Wide-field fundus image from infant ROP screening.
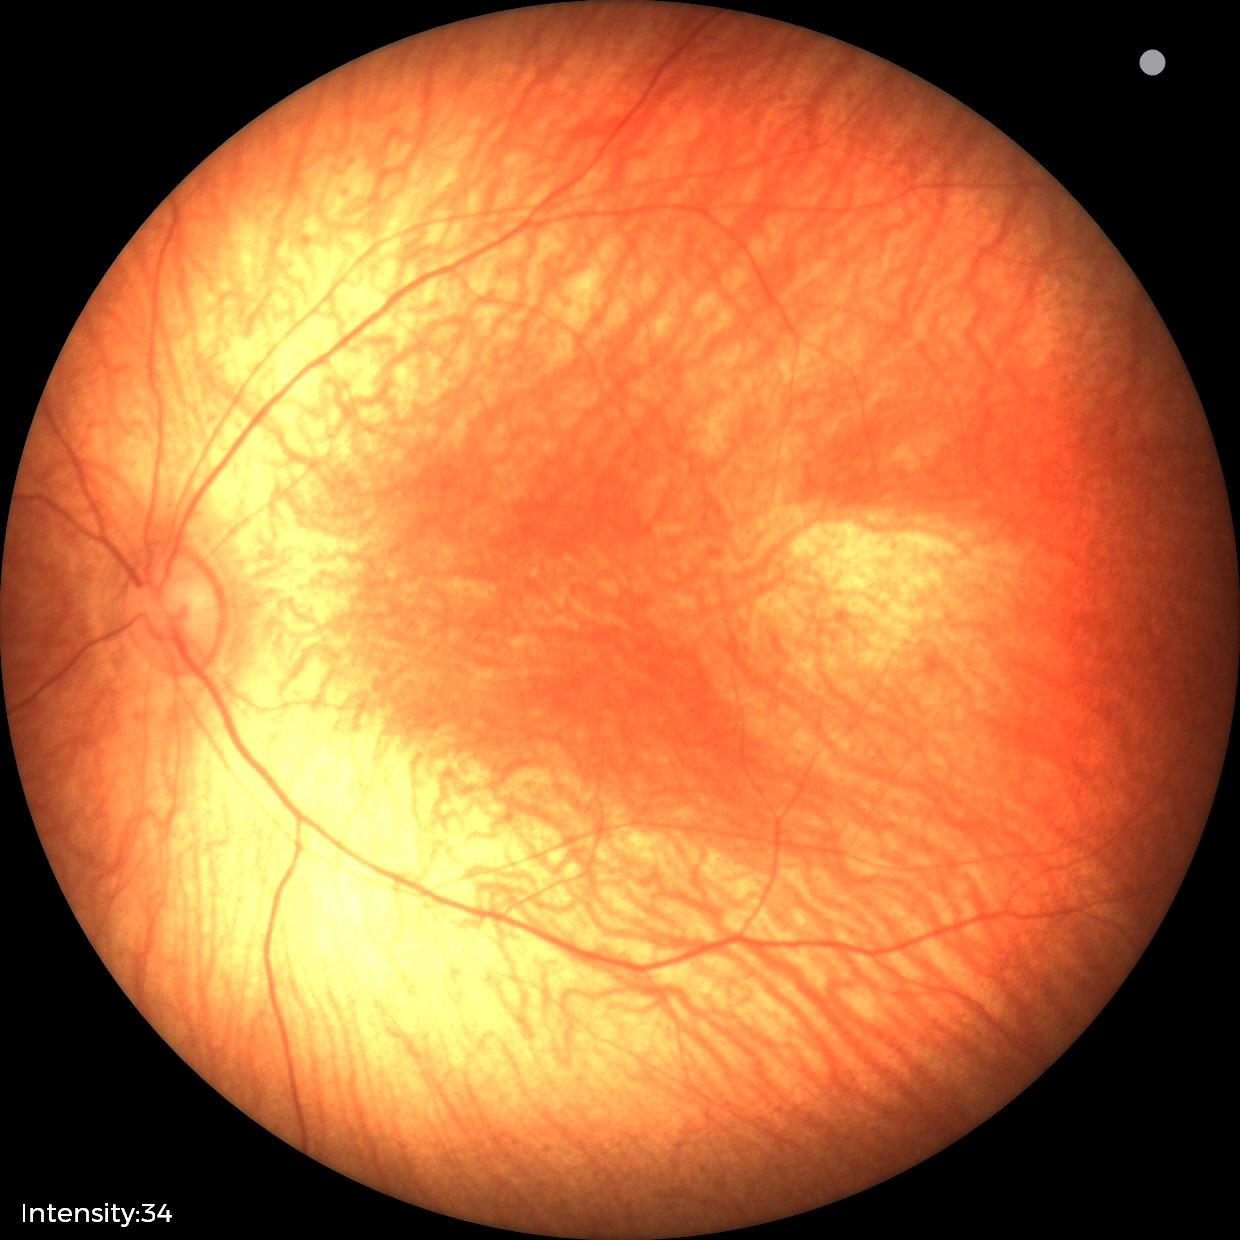 Screening diagnosis = no abnormalities.